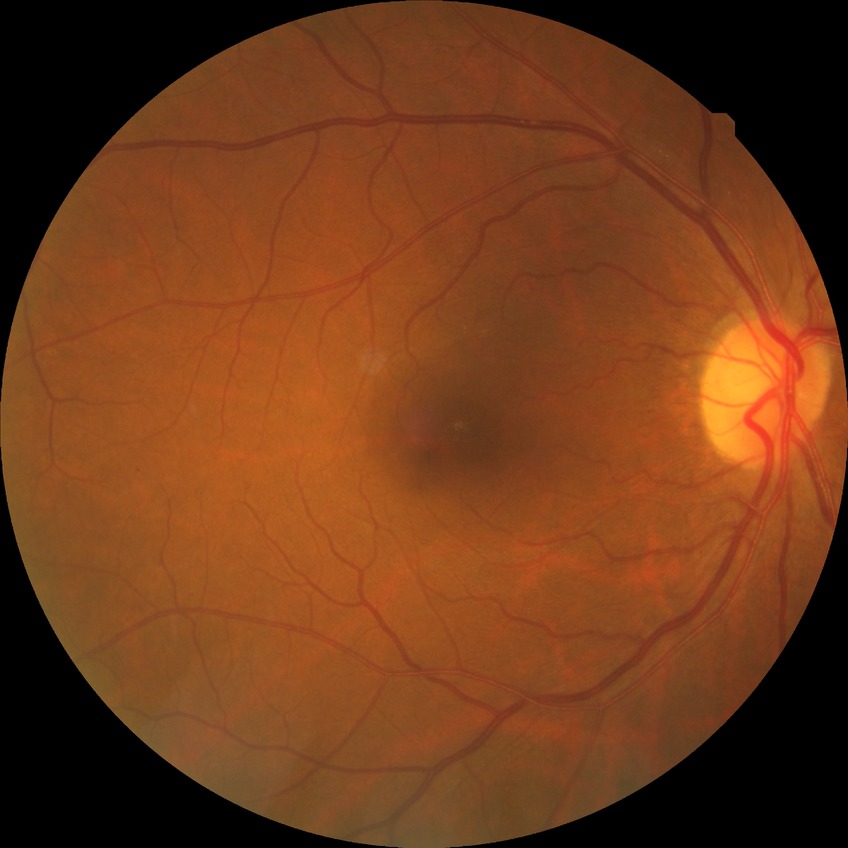
Diabetic retinopathy (DR) is simple diabetic retinopathy (SDR).